Pediatric wide-field fundus photograph:
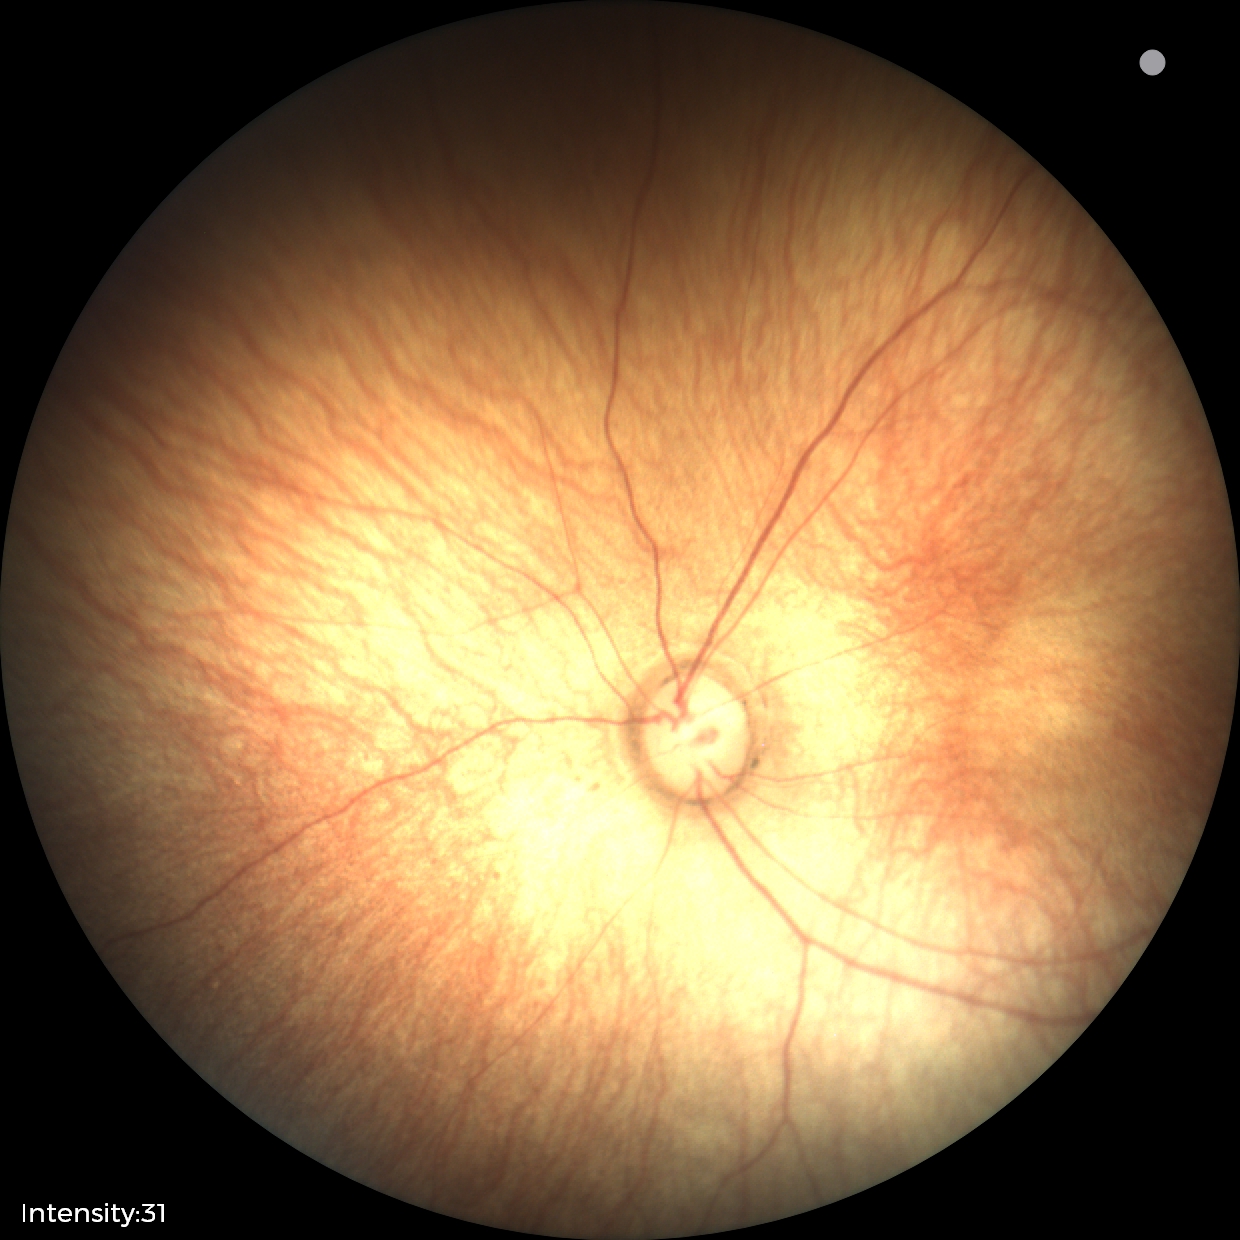

Screening examination with no abnormal retinal findings.